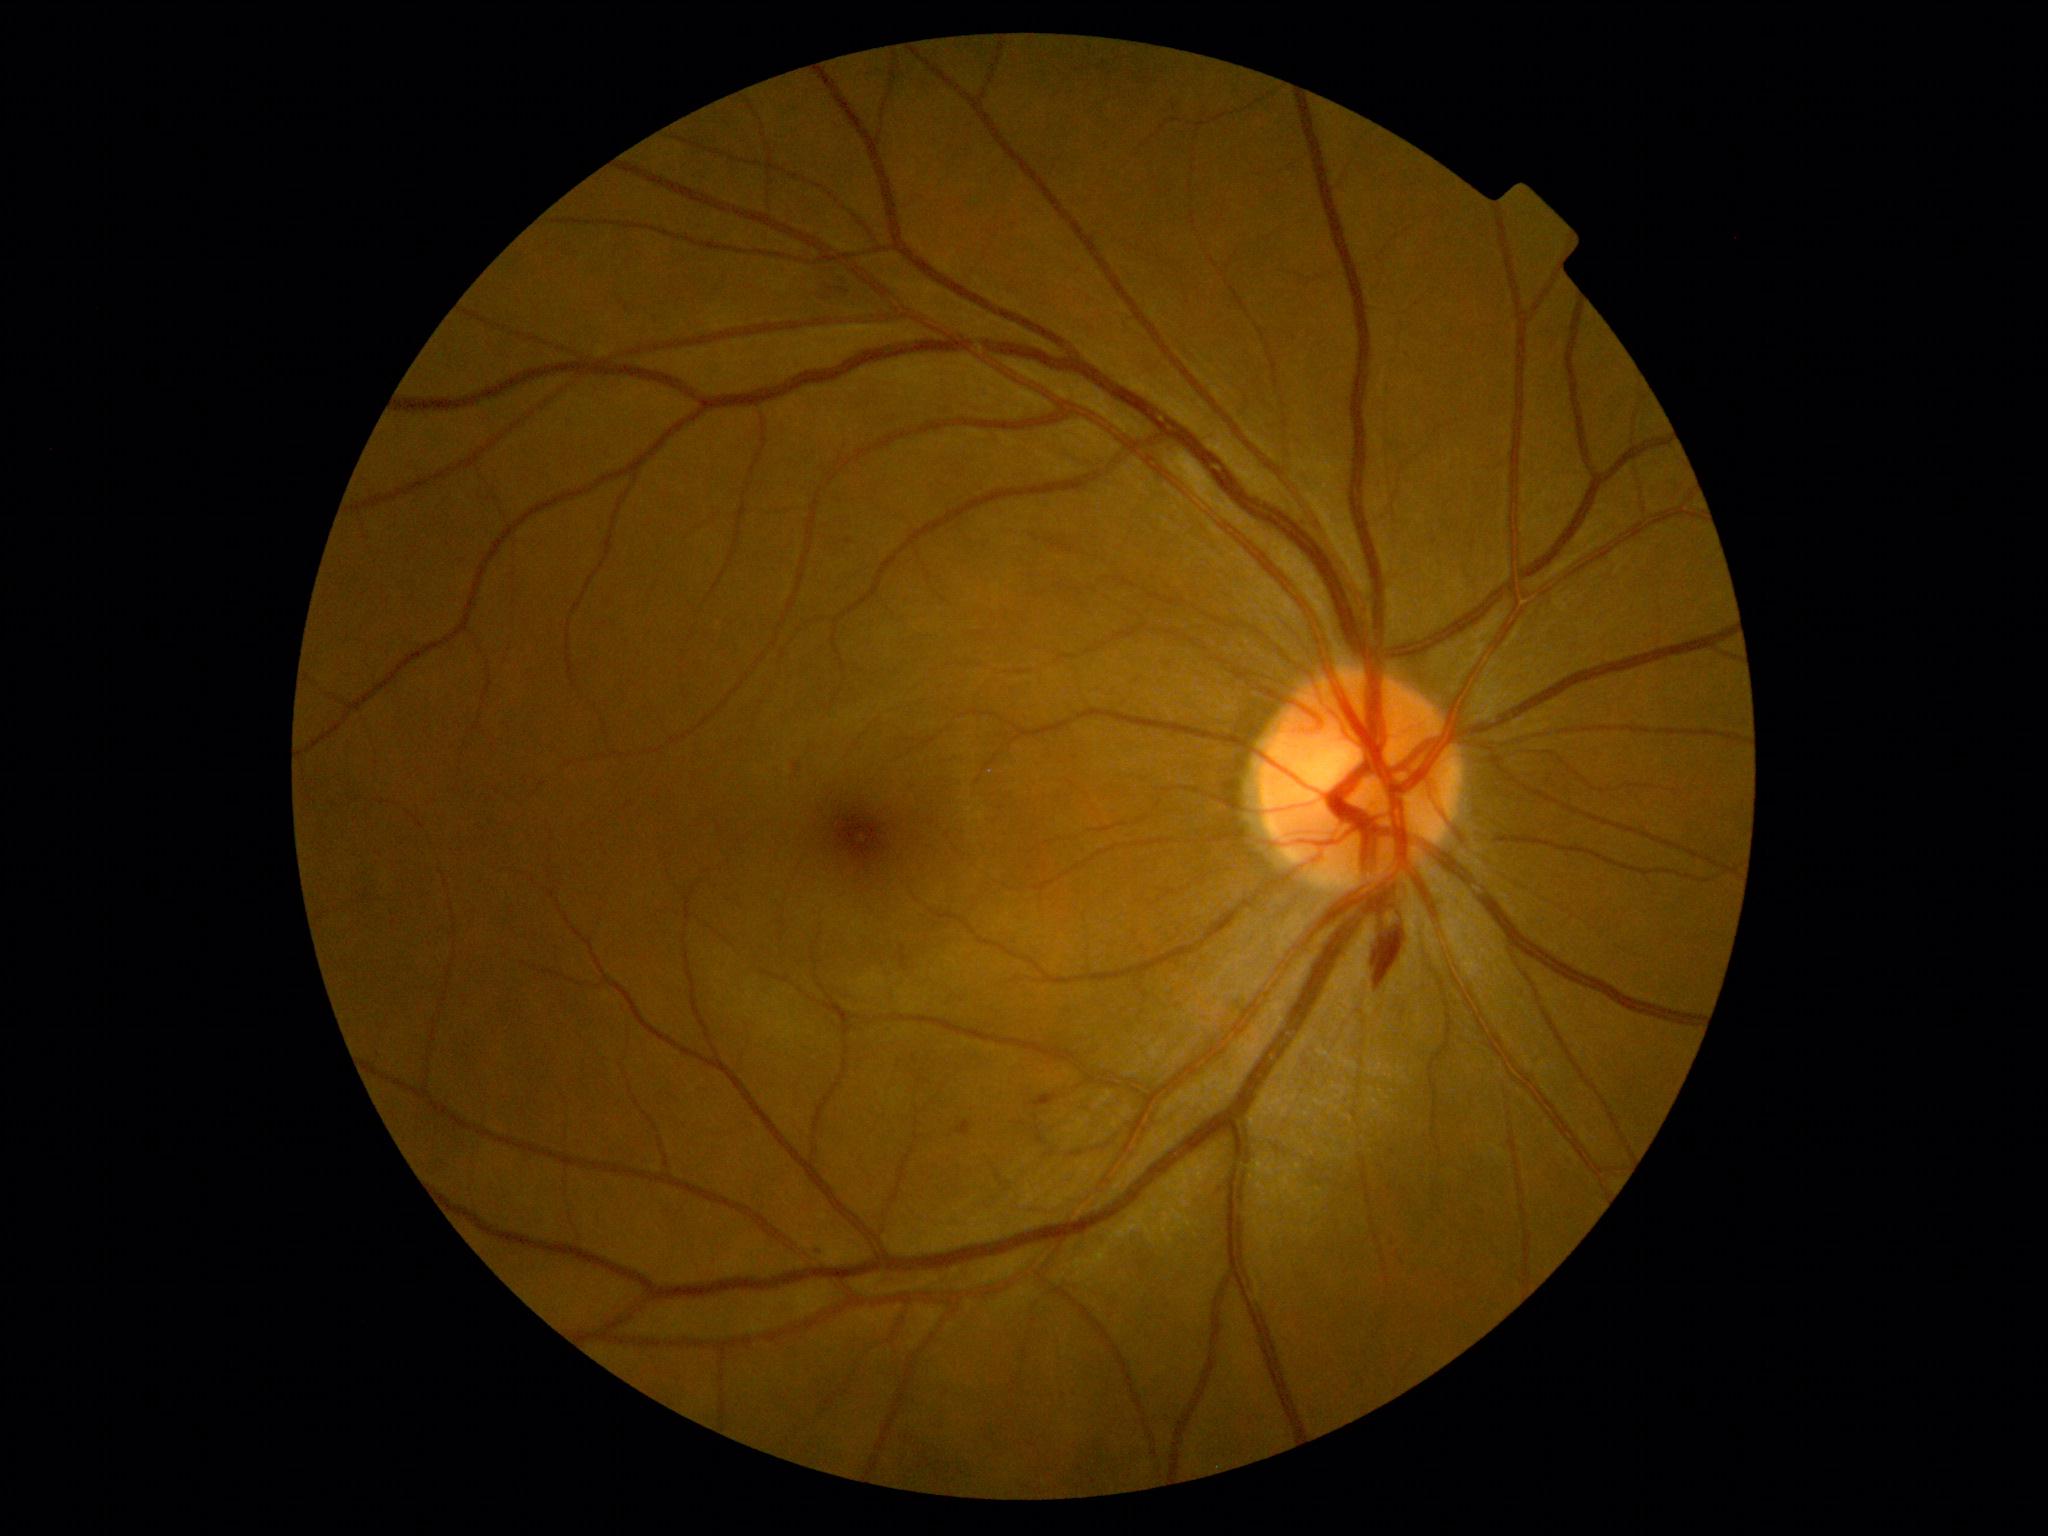

Diabetic retinopathy severity: grade 2 (moderate NPDR); non-proliferative diabetic retinopathy
Lesions:
• hemorrhages: 830, 282, 845, 296; 1376, 938, 1405, 986
• microaneurysms: 1028, 1094, 1058, 1109; 845, 539, 854, 545; 957, 1120, 971, 1137; 794, 764, 801, 772; 809, 1246, 822, 1253
• hard exudates: none
• soft exudates: none